848x848 — 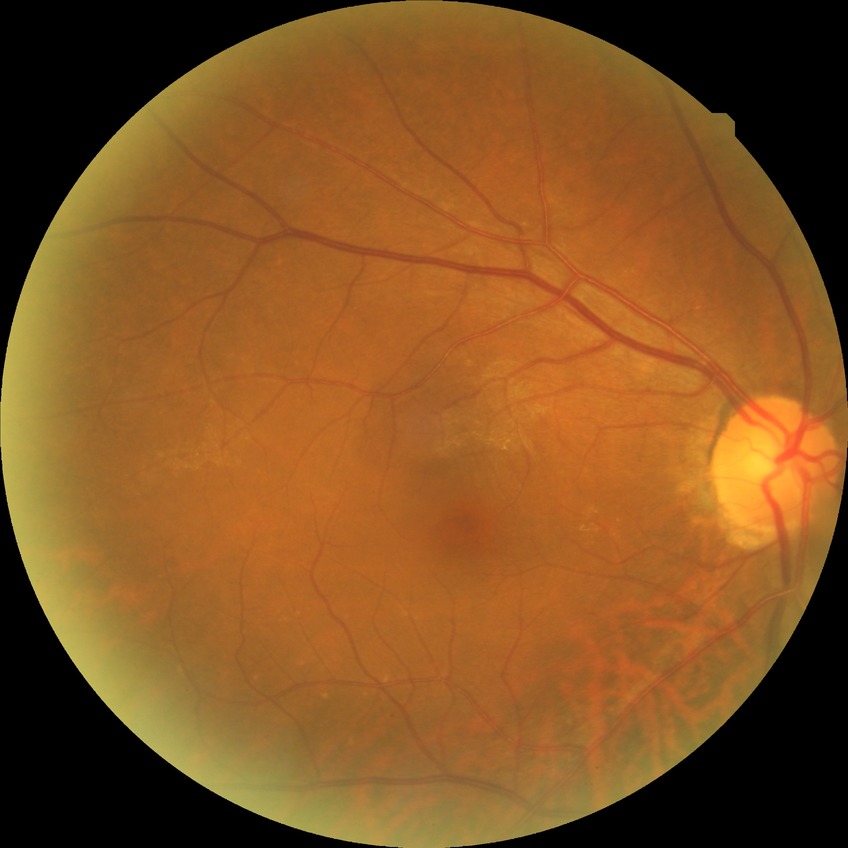

davis_grade: no diabetic retinopathy (NDR)